Fundus photo, 2048 x 1536 pixels:
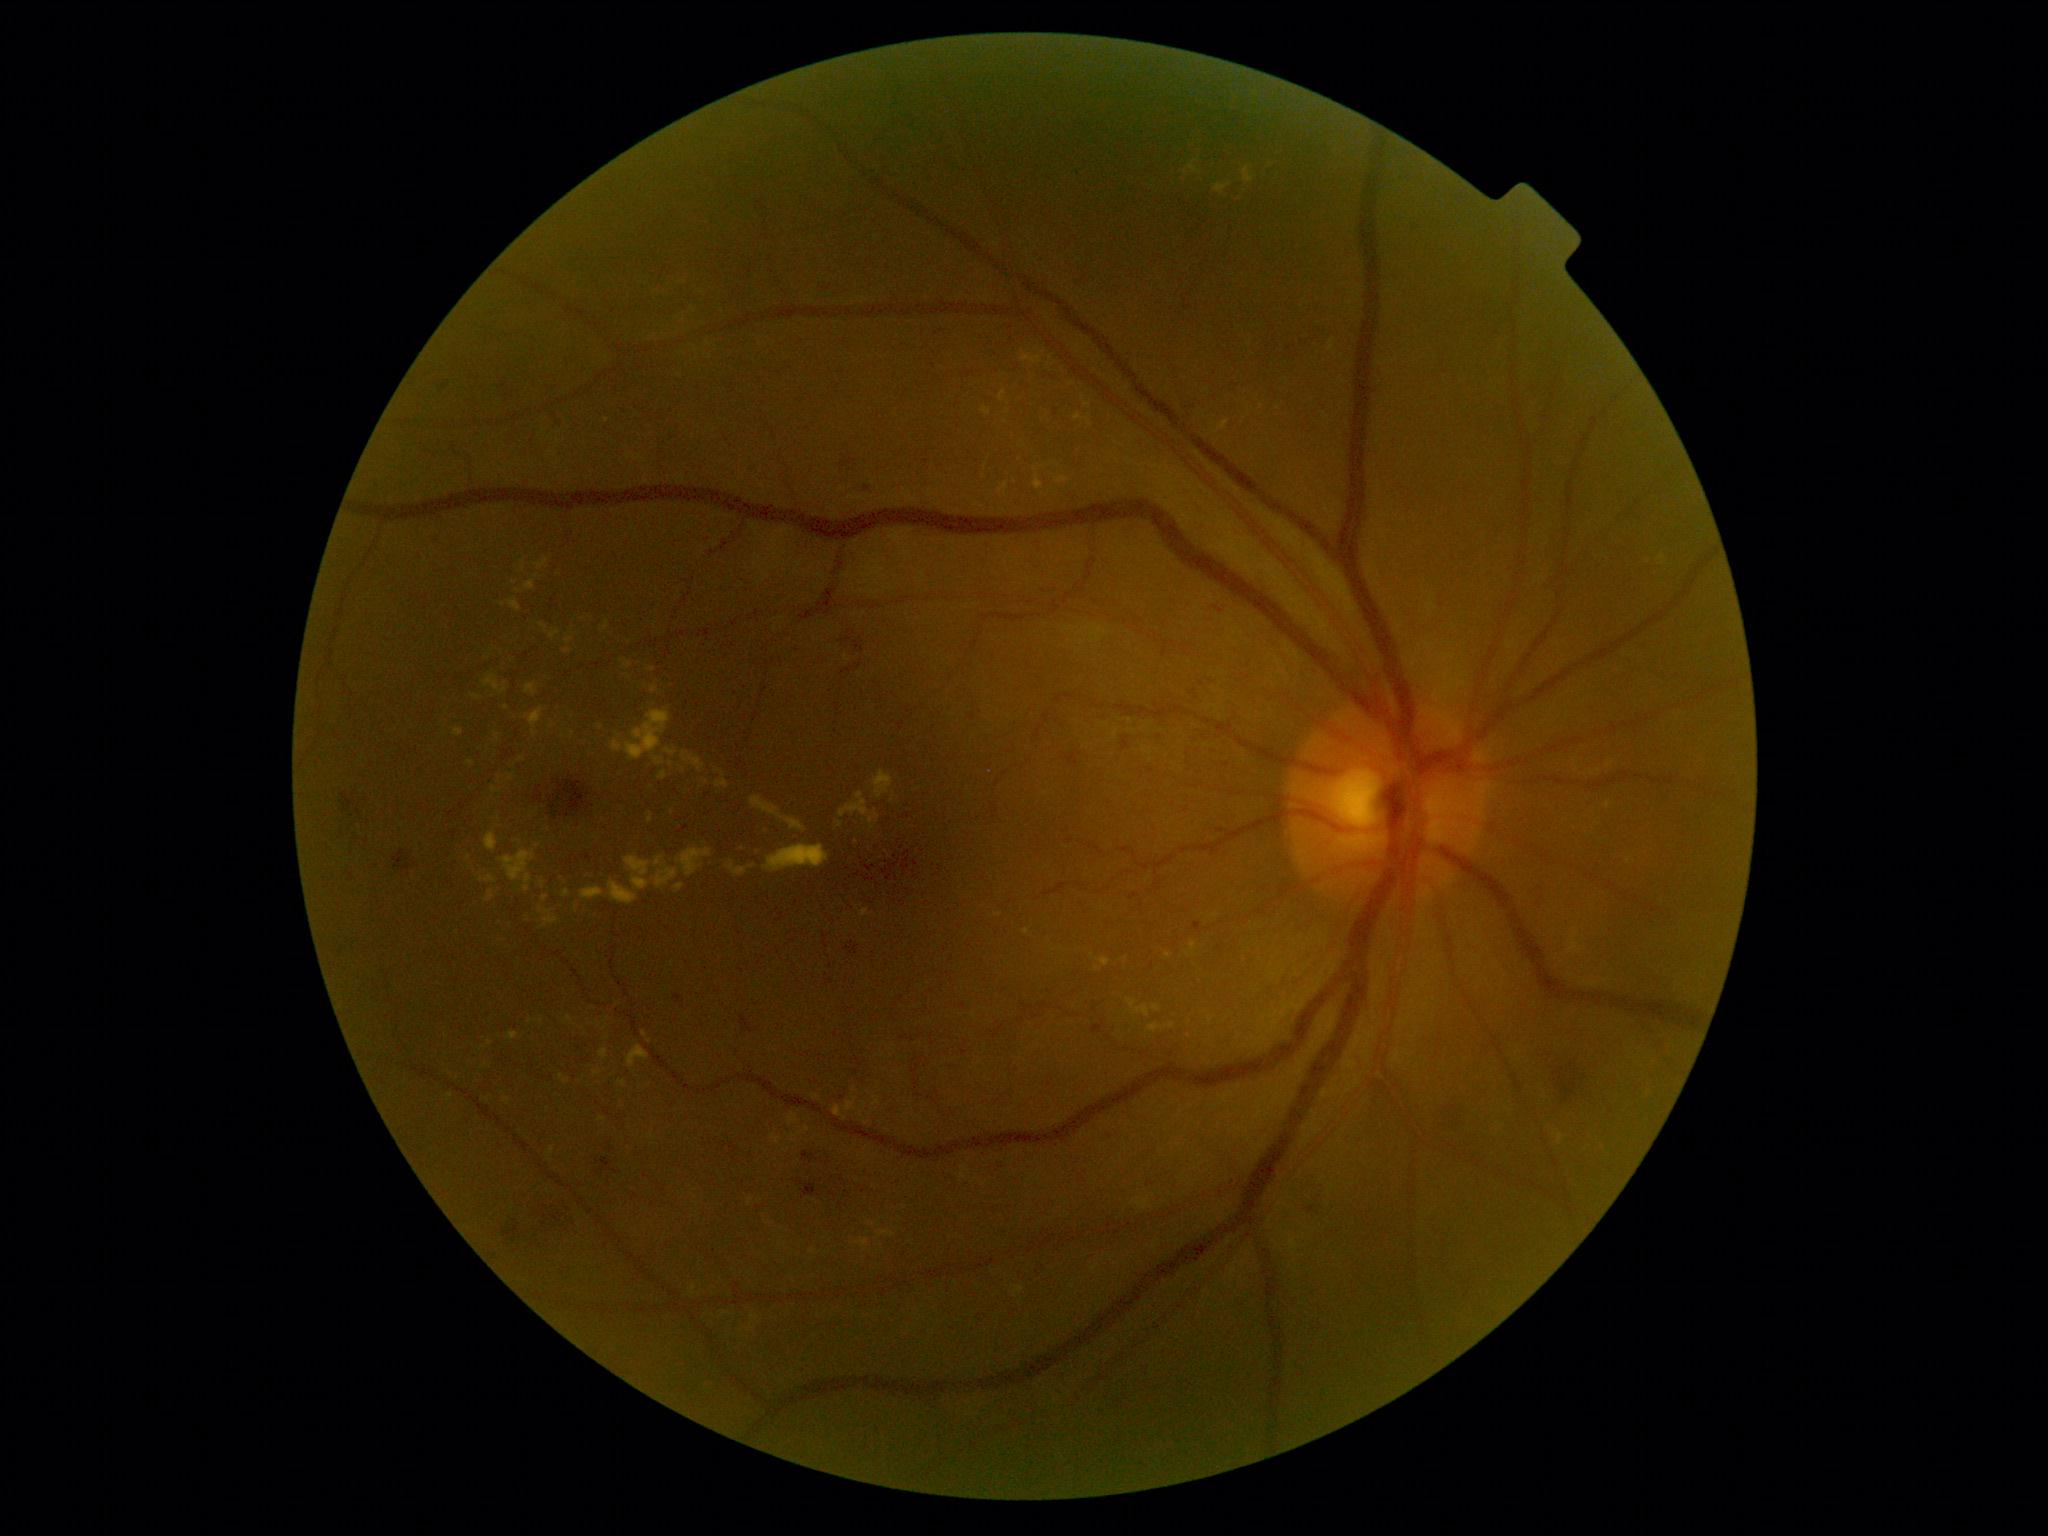
Diabetic retinopathy (DR): grade 2 (moderate NPDR)
Representative lesions:
hard exudates (EXs) (subset) = {"left": 525, "top": 580, "right": 535, "bottom": 591} | {"left": 833, "top": 1105, "right": 847, "bottom": 1121} | {"left": 1208, "top": 1015, "right": 1216, "bottom": 1024} | {"left": 492, "top": 788, "right": 502, "bottom": 793} | {"left": 562, "top": 891, "right": 571, "bottom": 898} | {"left": 454, "top": 727, "right": 463, "bottom": 737} | {"left": 525, "top": 683, "right": 537, "bottom": 696} | {"left": 484, "top": 674, "right": 508, "bottom": 695} | {"left": 998, "top": 483, "right": 1009, "bottom": 494} | {"left": 499, "top": 849, "right": 535, "bottom": 892}
Smaller EXs around [x=471, y=764] | [x=595, y=837] | [x=537, y=576] | [x=1608, y=805] | [x=1191, y=1022] | [x=645, y=1034] | [x=503, y=605] | [x=601, y=1120]